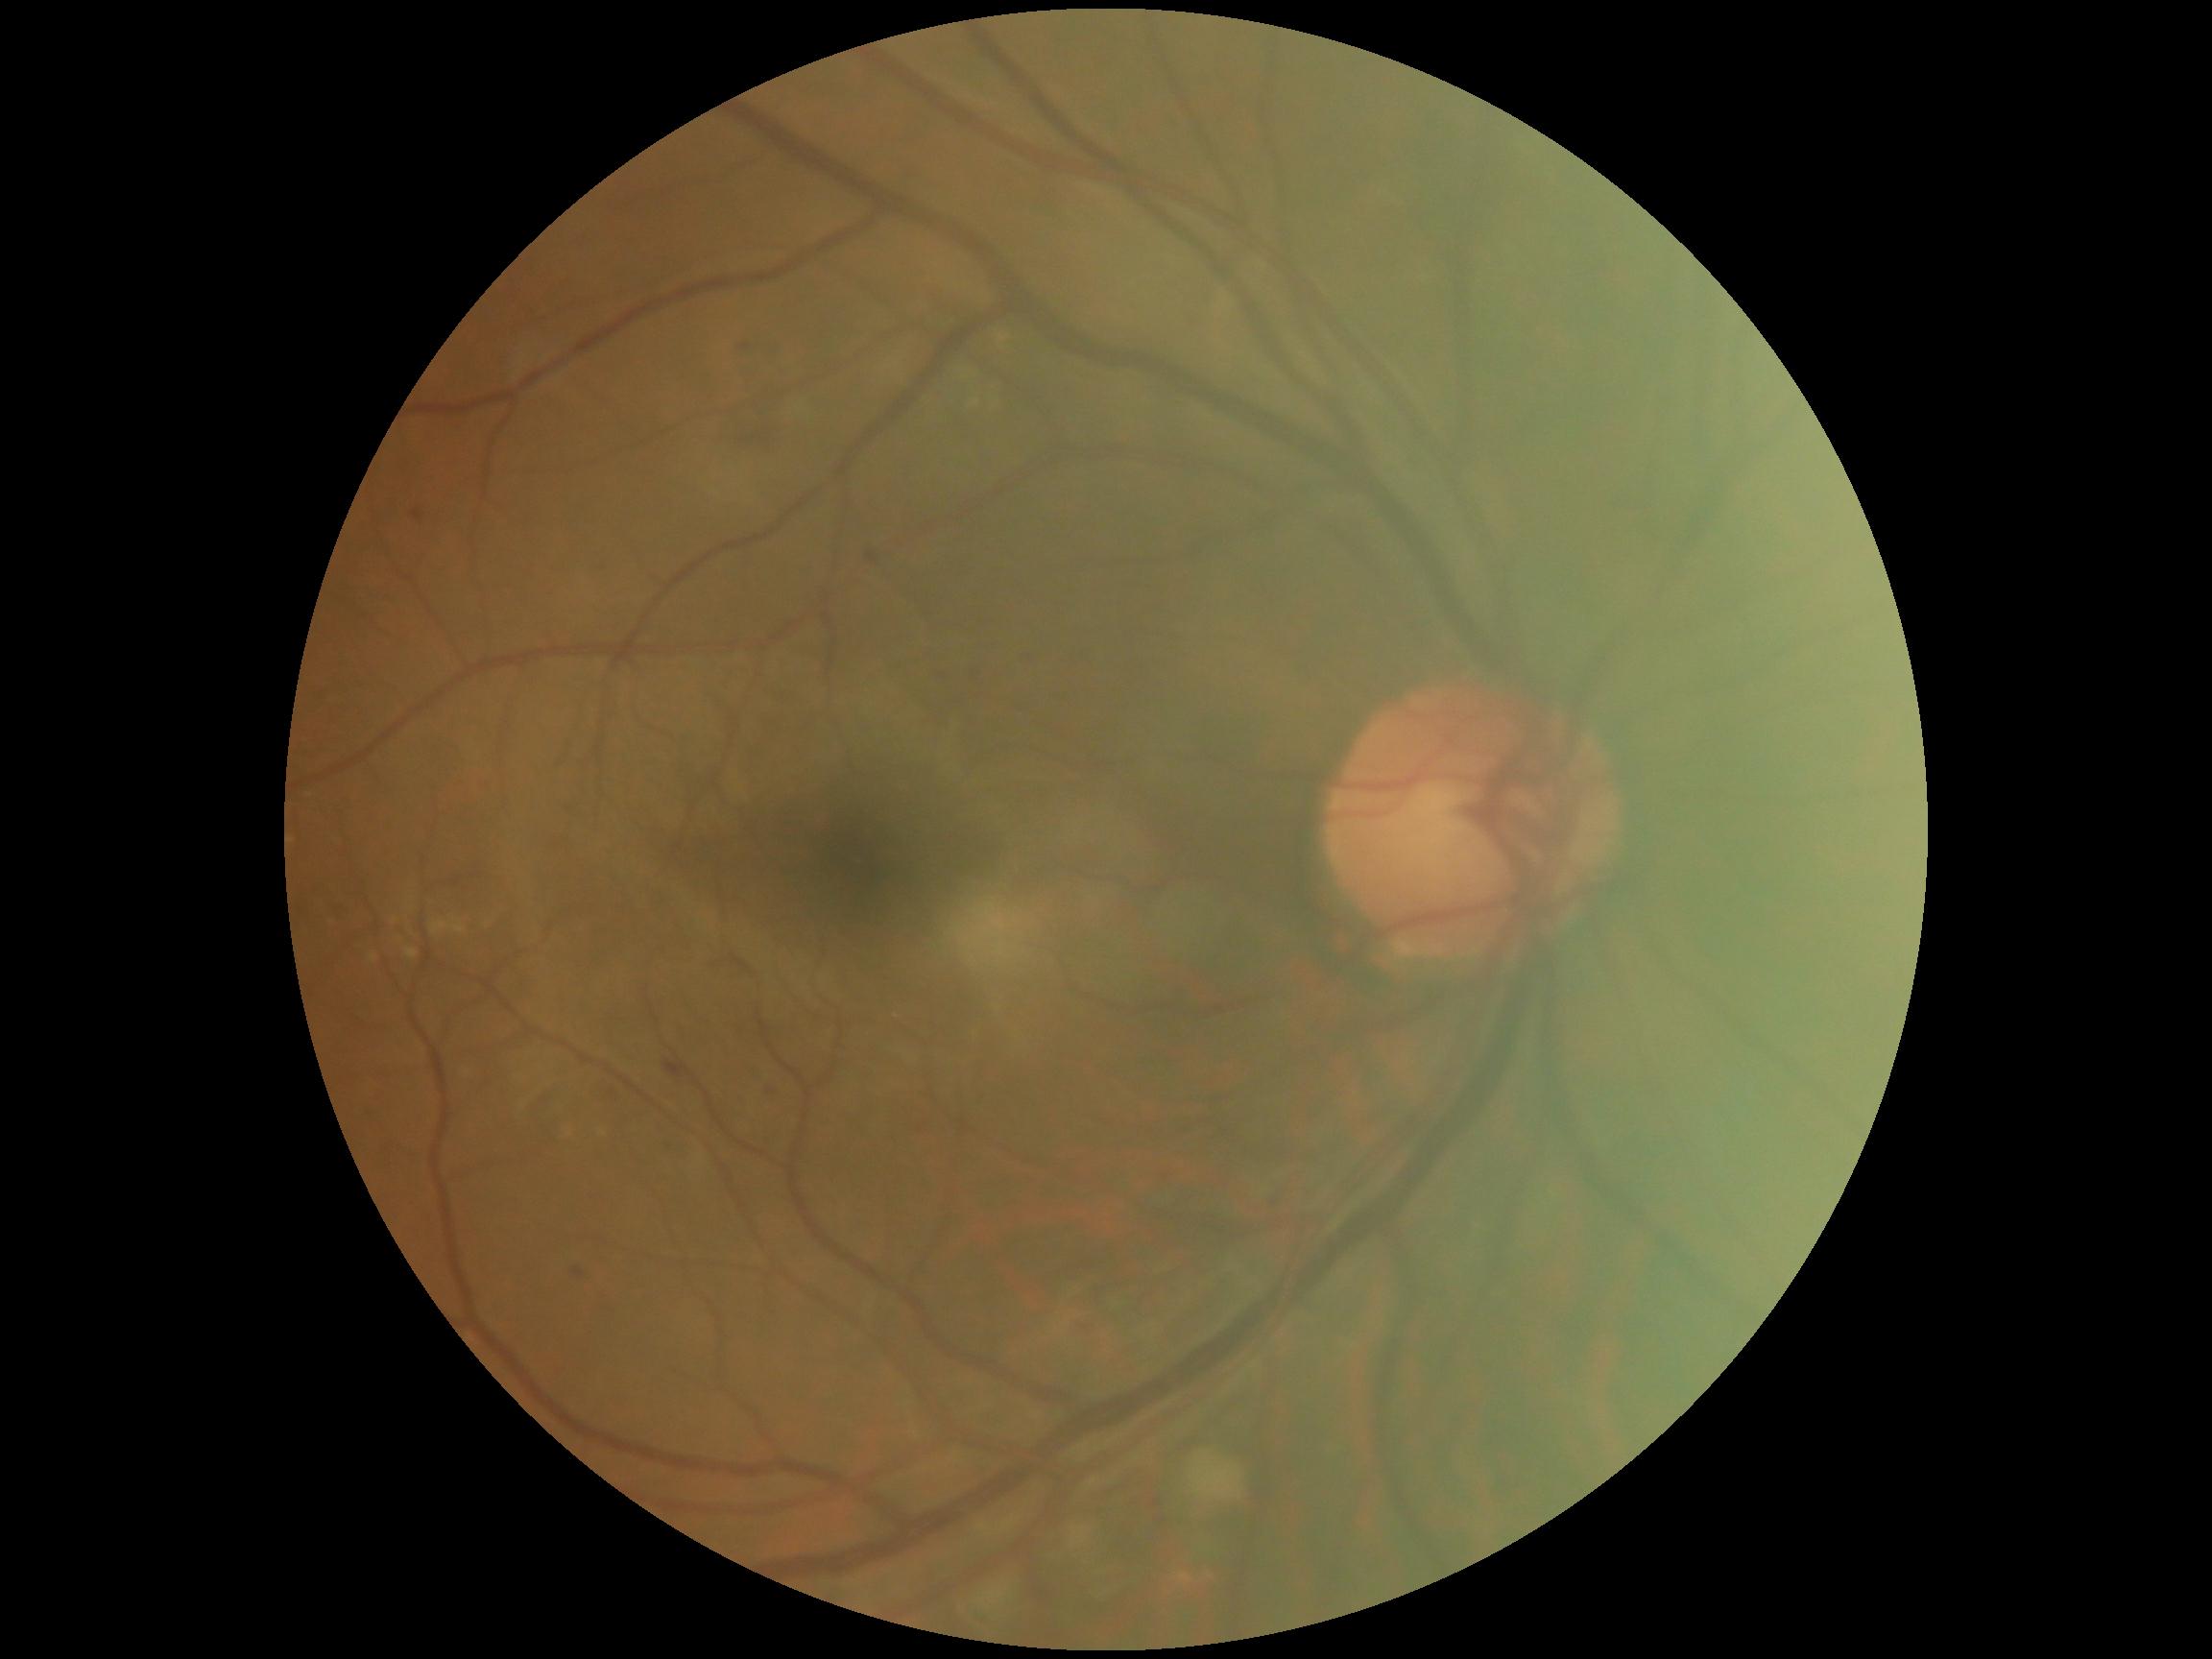
dr_grade: 2